FOV: 45 degrees: 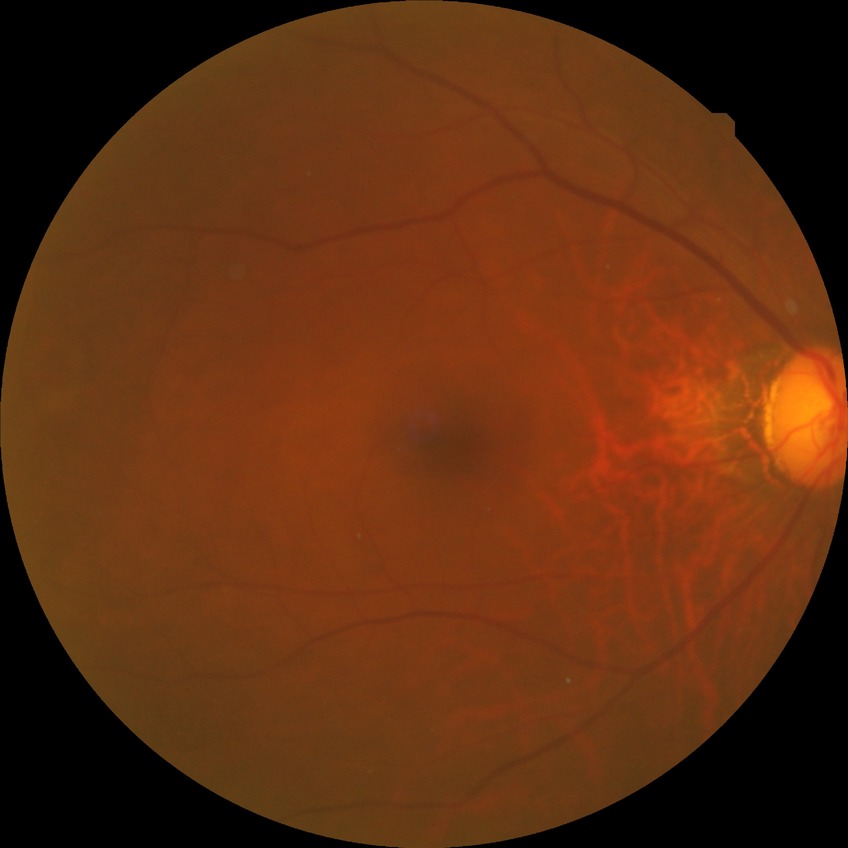

davis_grade: no diabetic retinopathy